640x480. Infant wide-field fundus photograph
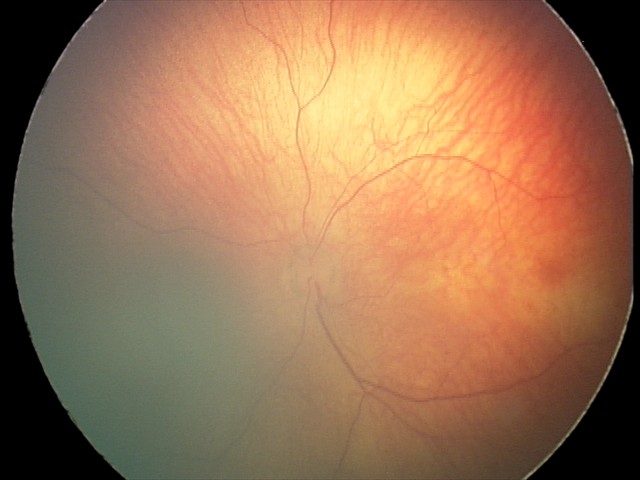

Normal screening examination.